CFP — 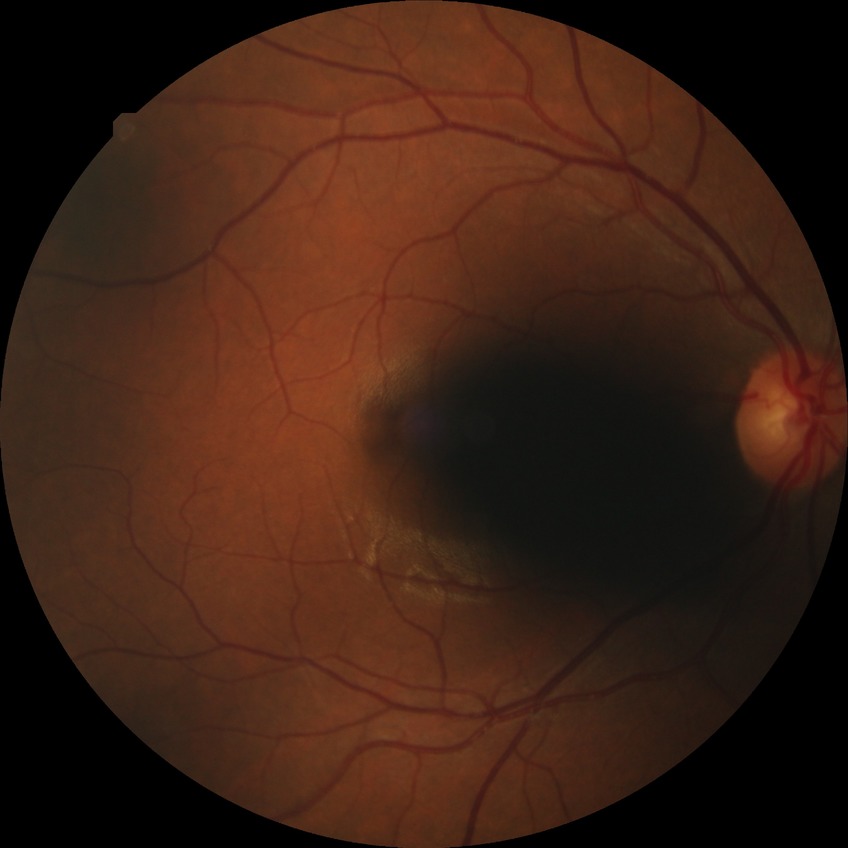
DR impression: no signs of DR
DR stage: NDR